FOV: 45 degrees, modified Davis grading — 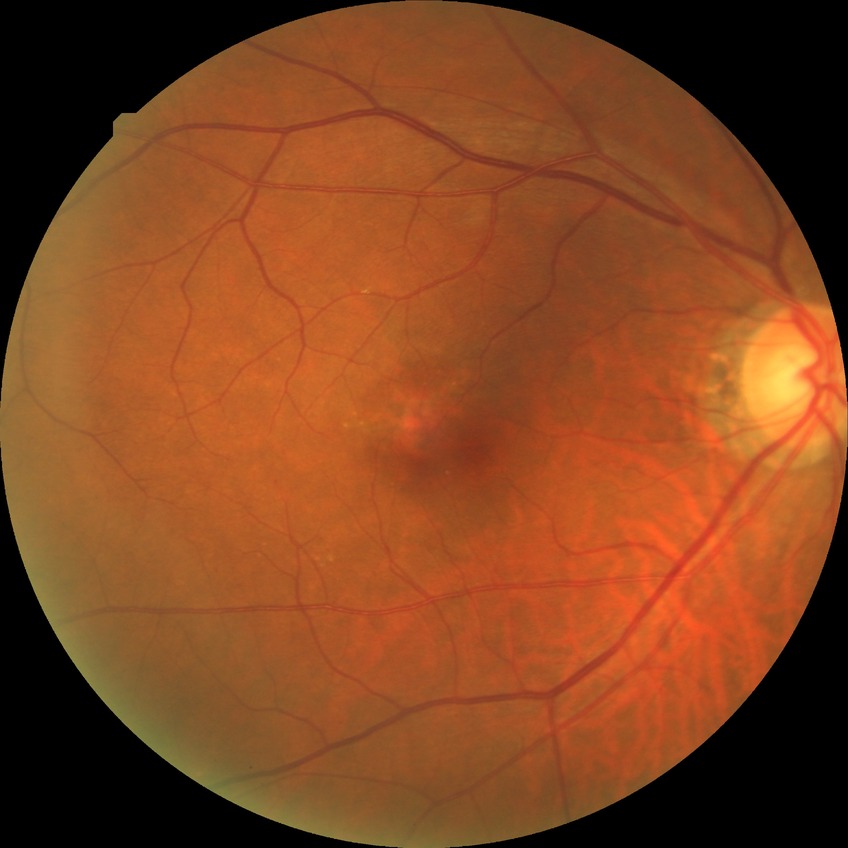
DR stage: NDR.
No DR findings.